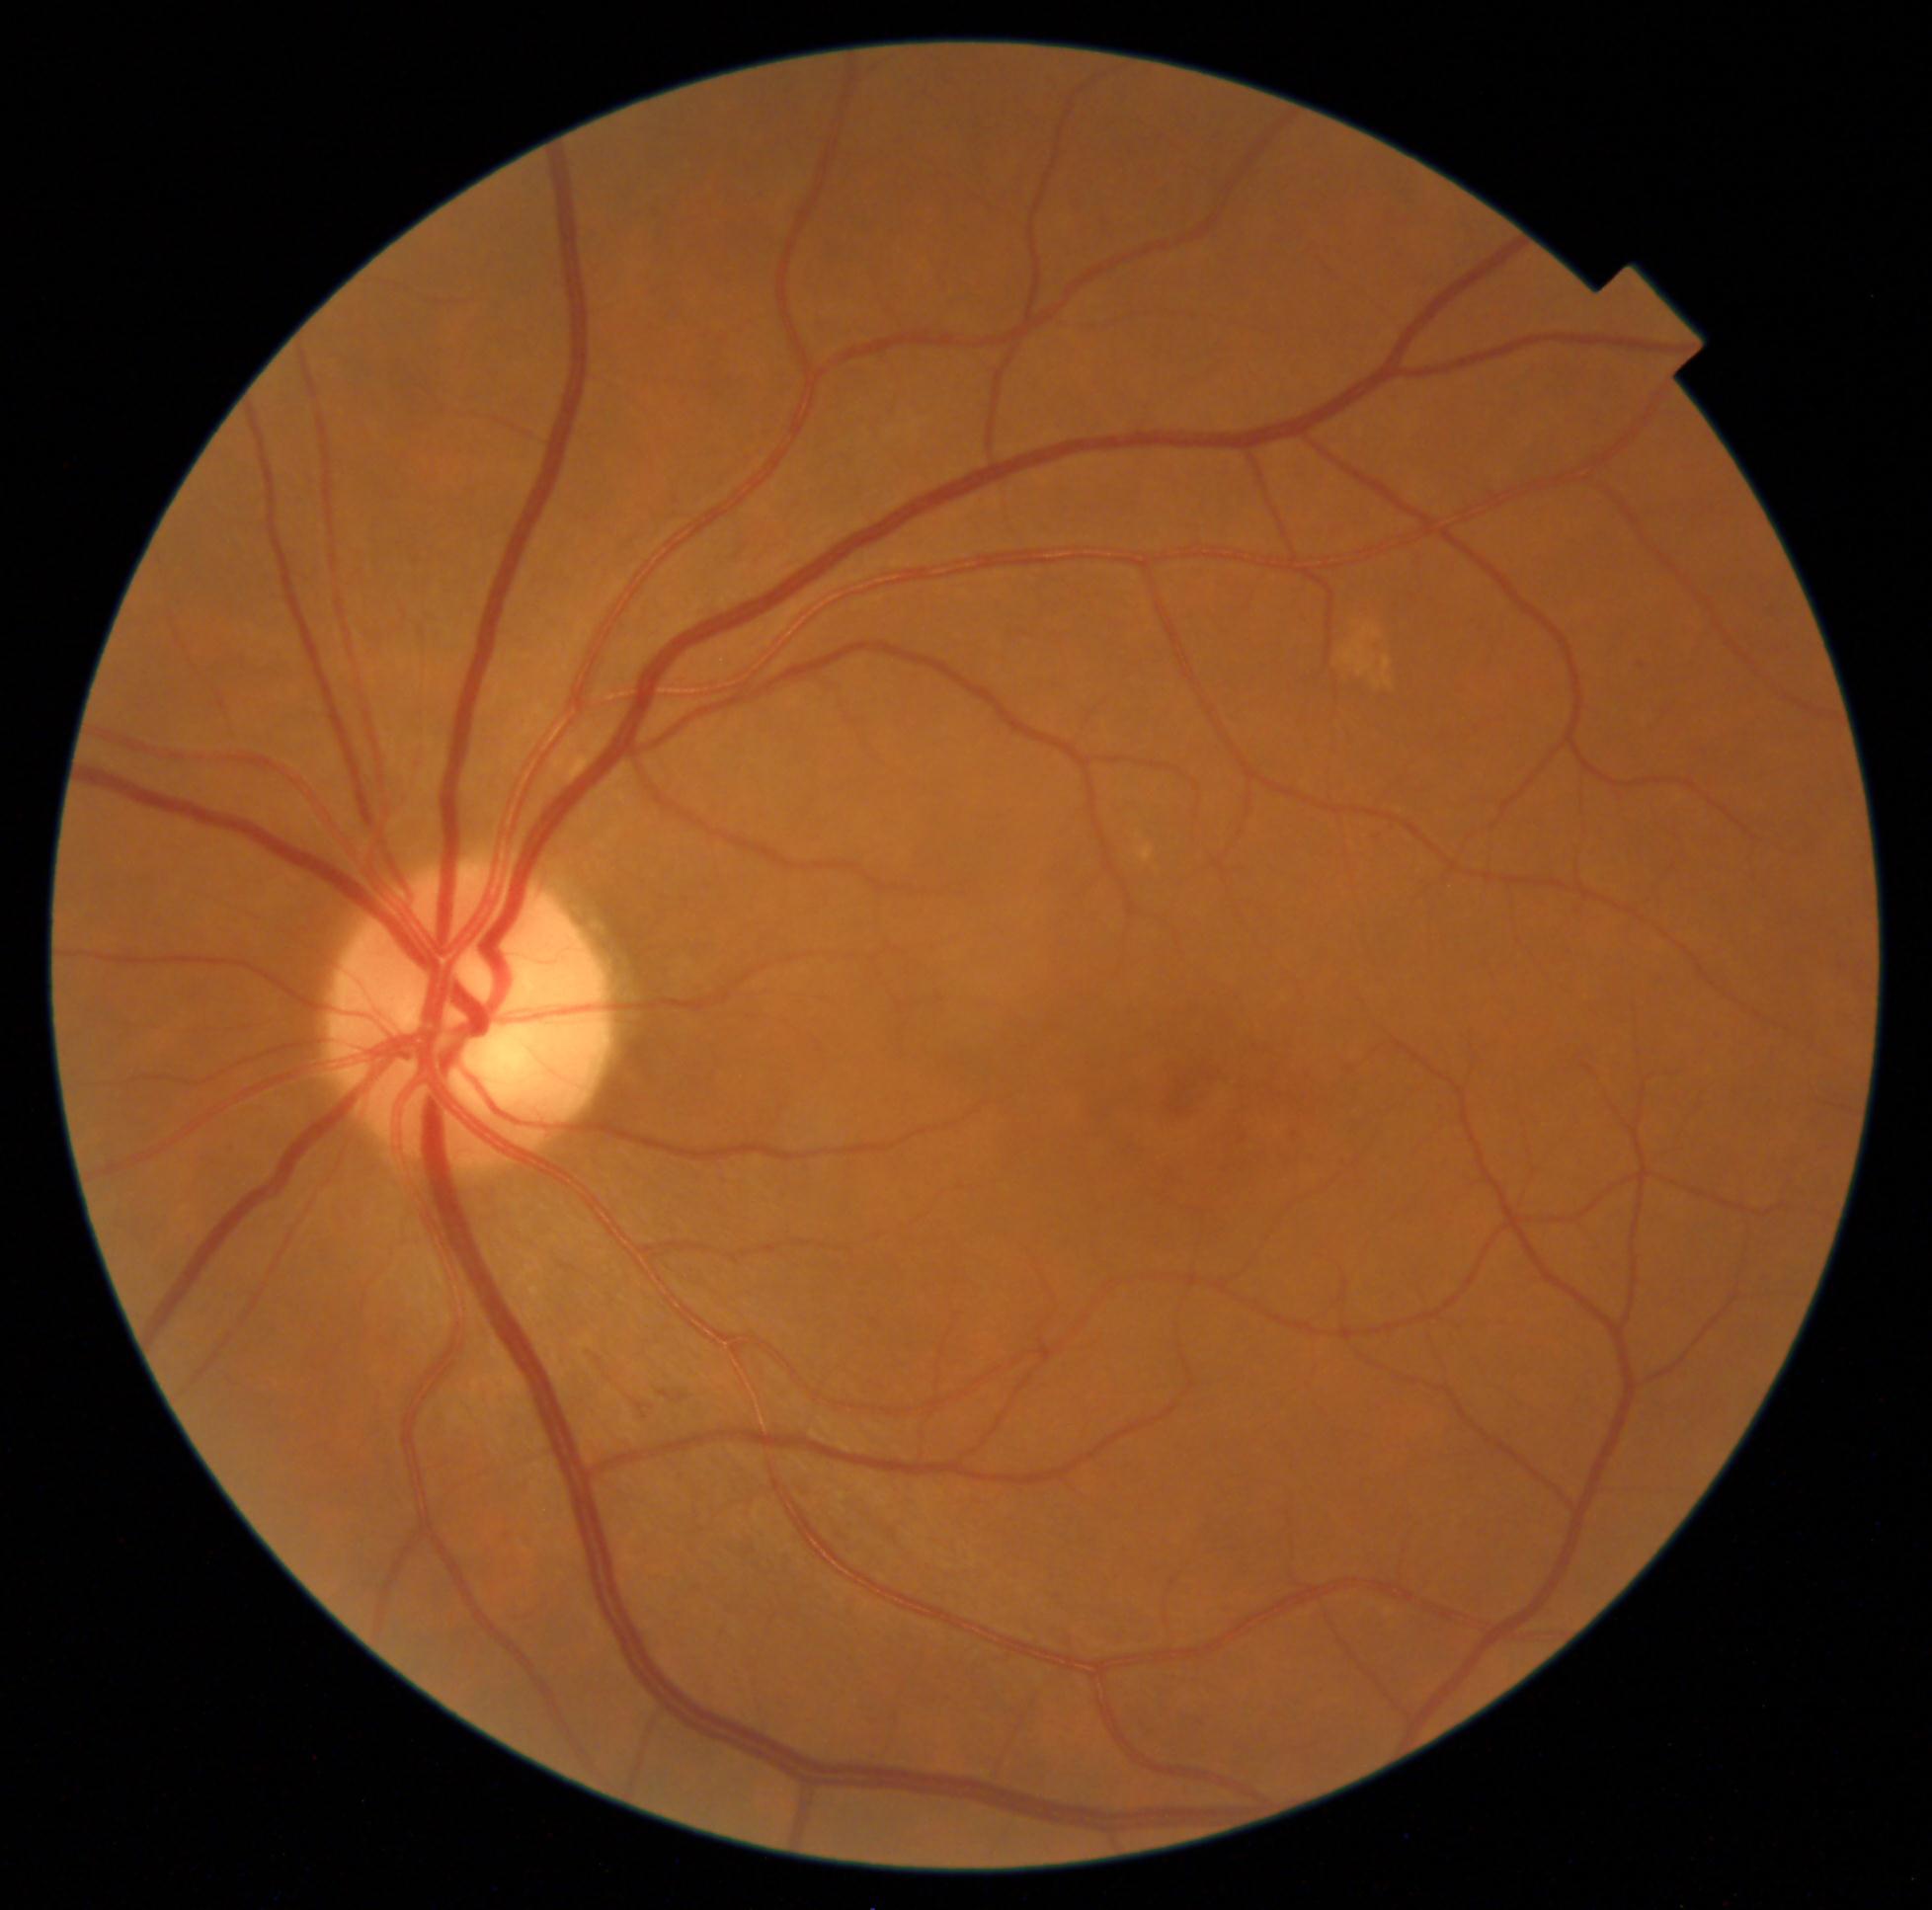

  dr_grade: moderate NPDR (grade 2)